Davis DR grading
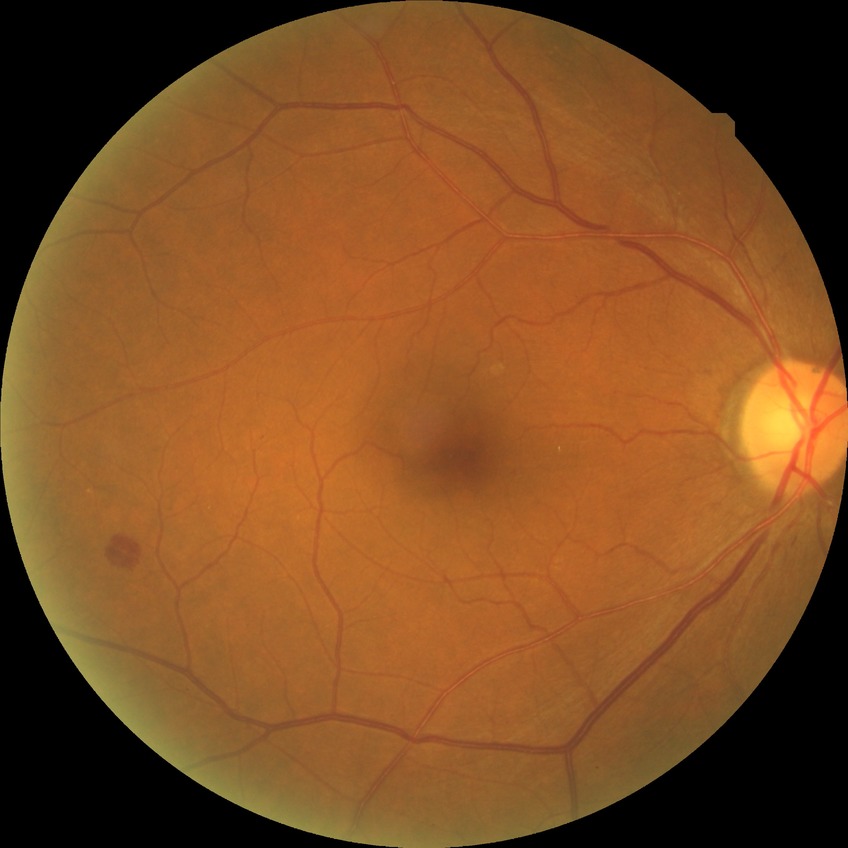

Retinopathy grade: simple diabetic retinopathy.